Wide-field fundus image from infant ROP screening: 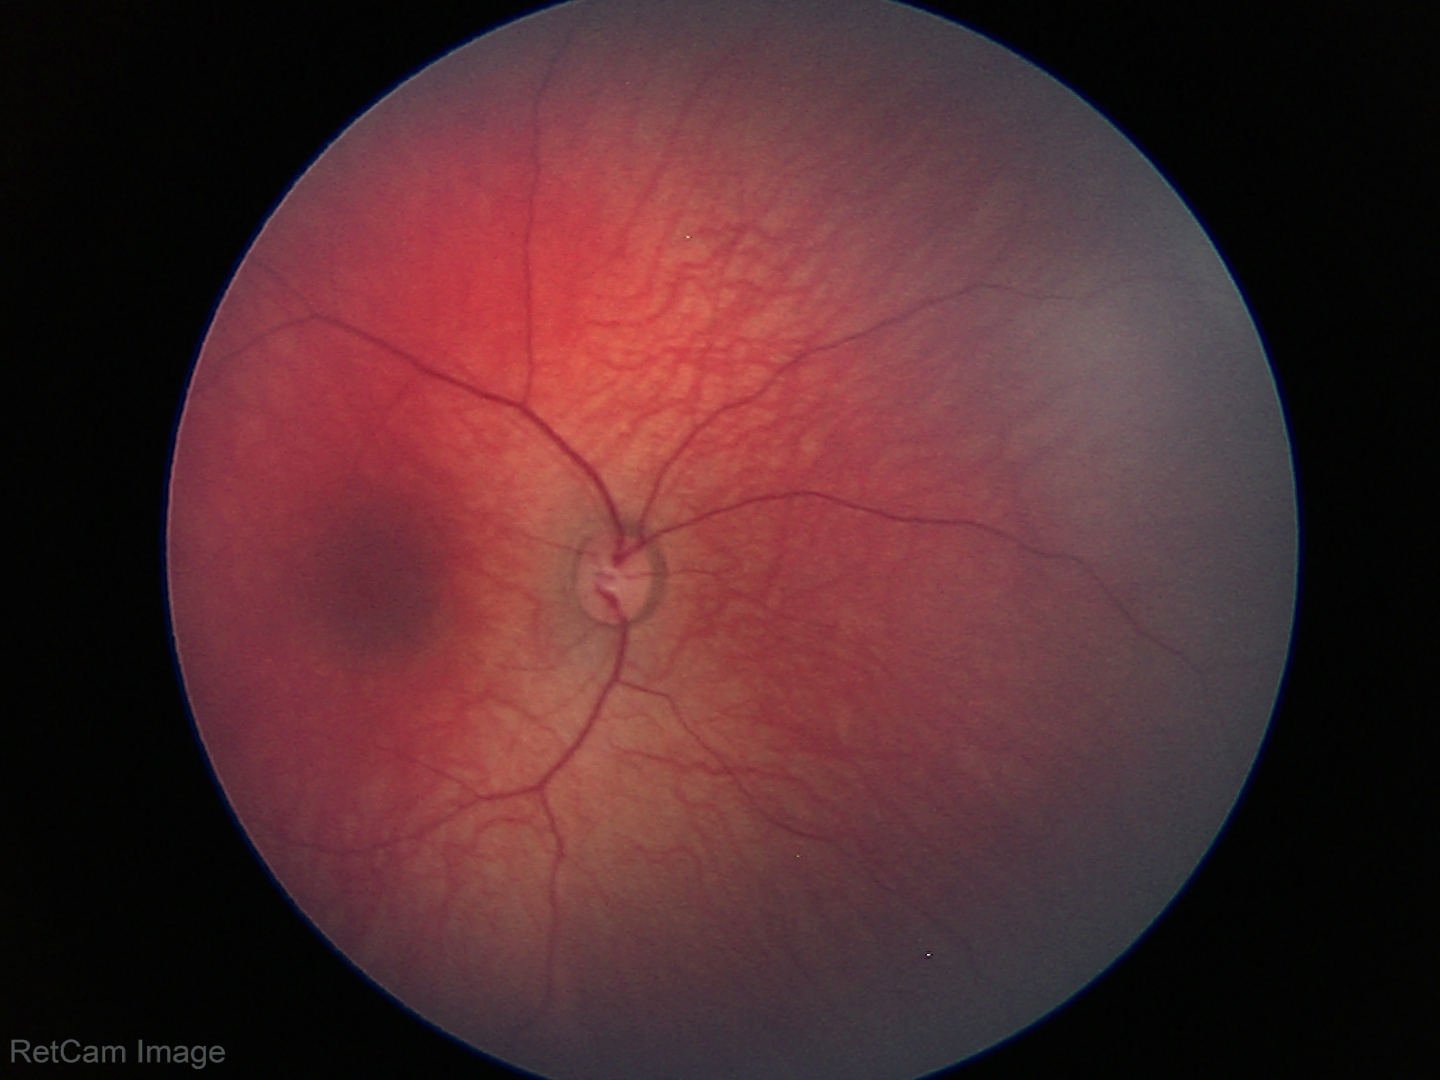 No retinal pathology identified on screening.